Color fundus photograph from a handheld portable camera — 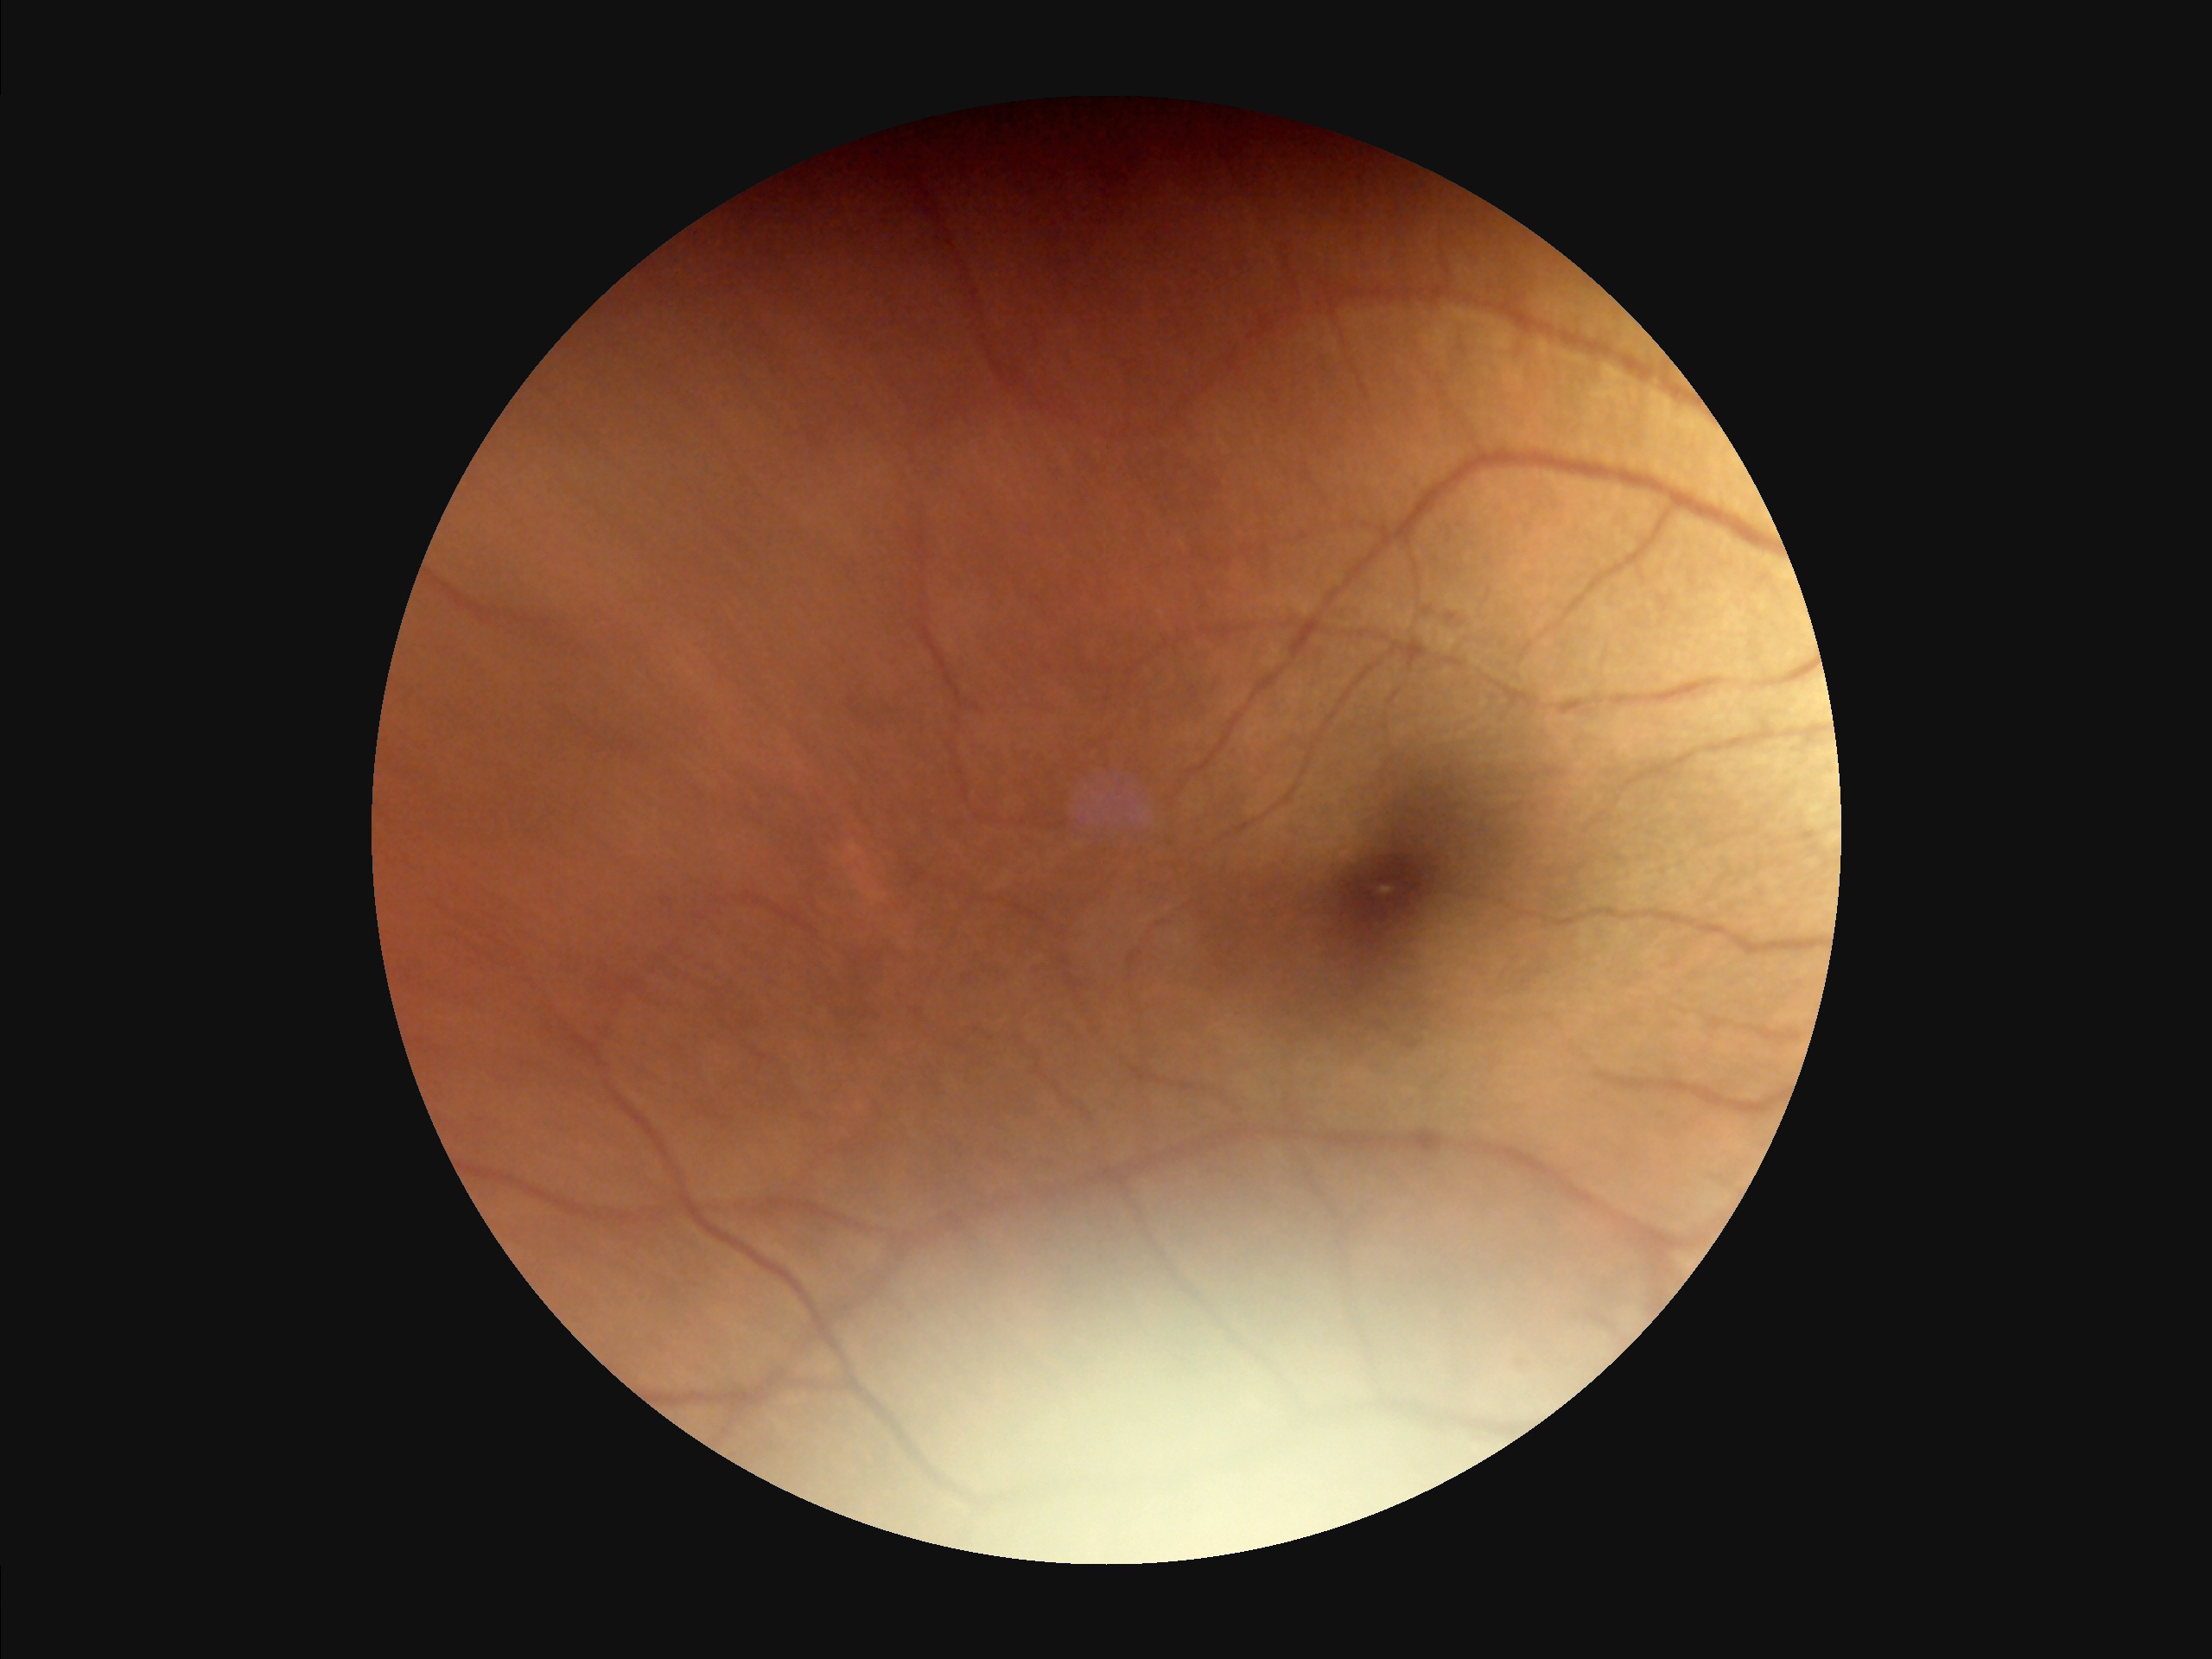
{"overall_quality": "poor", "clarity": "poor", "contrast": "poor", "illumination": "poor"}